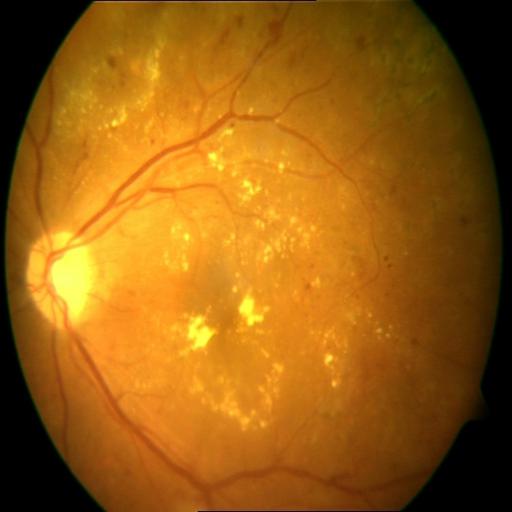

2 findings. Color fundus photograph showing hemorrhagic retinopathy and exudation.